848x848px; 45° FOV:
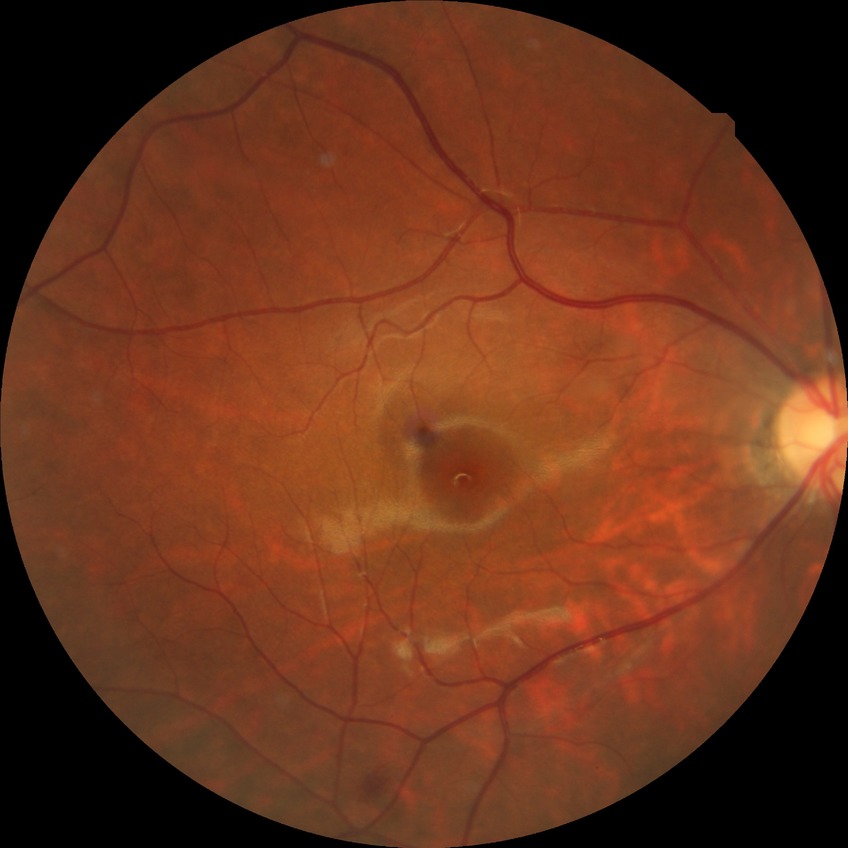
Findings:
- diabetic retinopathy (DR) — no diabetic retinopathy (NDR)